Image size 1240x1240 · infant wide-field retinal image · acquired on the Phoenix ICON
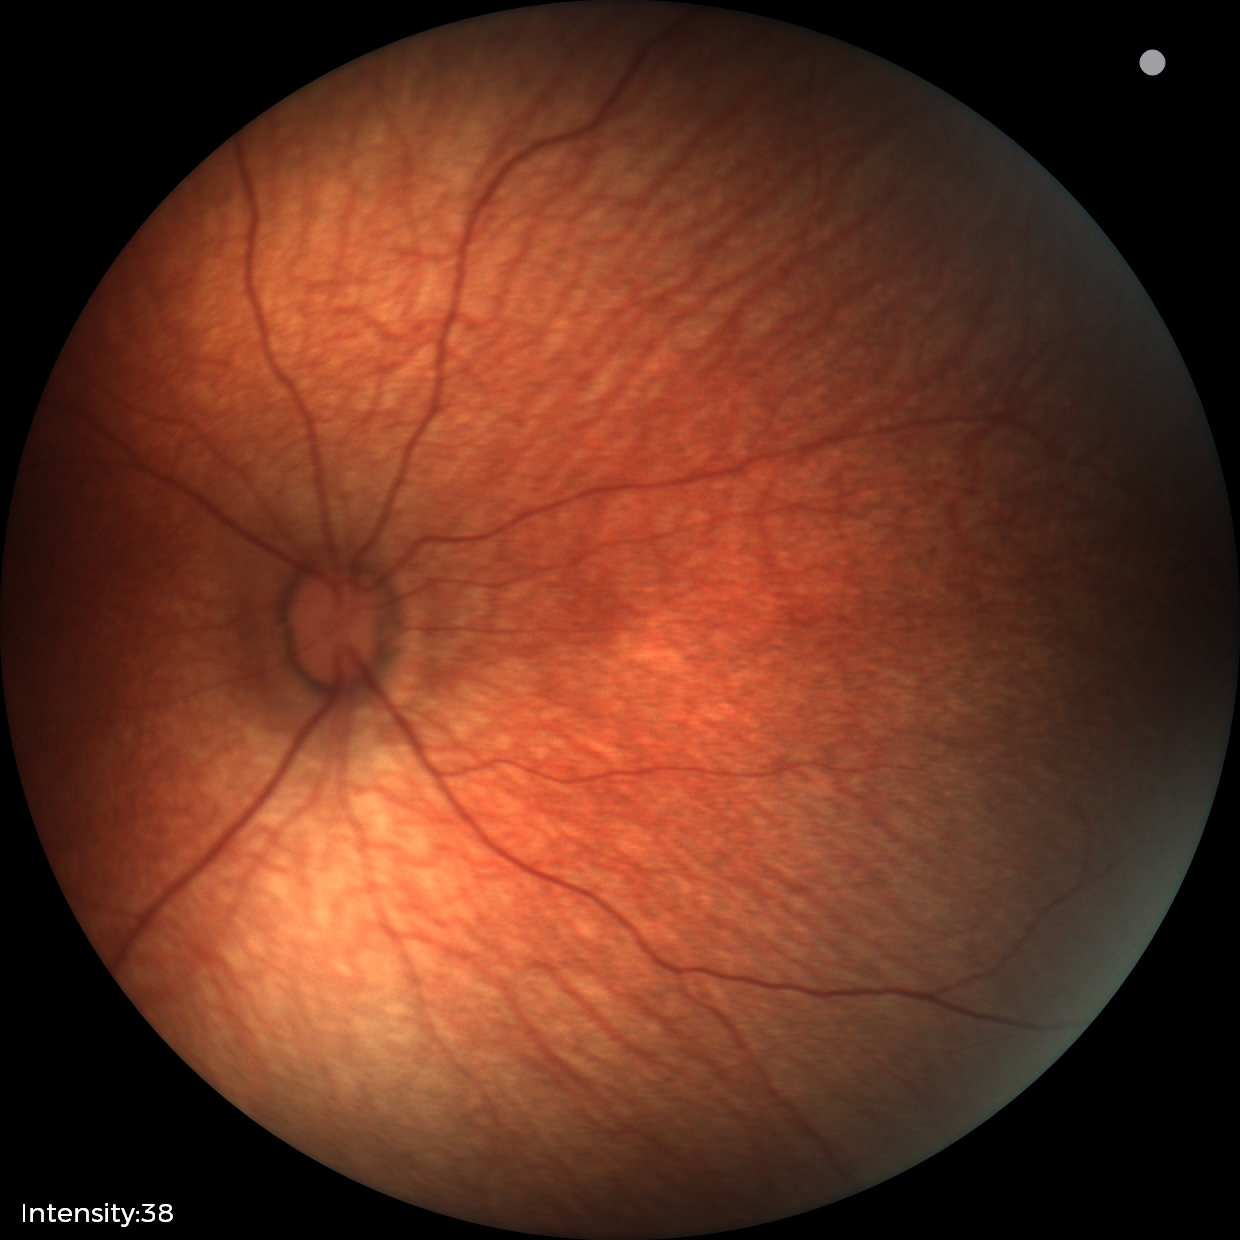

Assessment = normal.